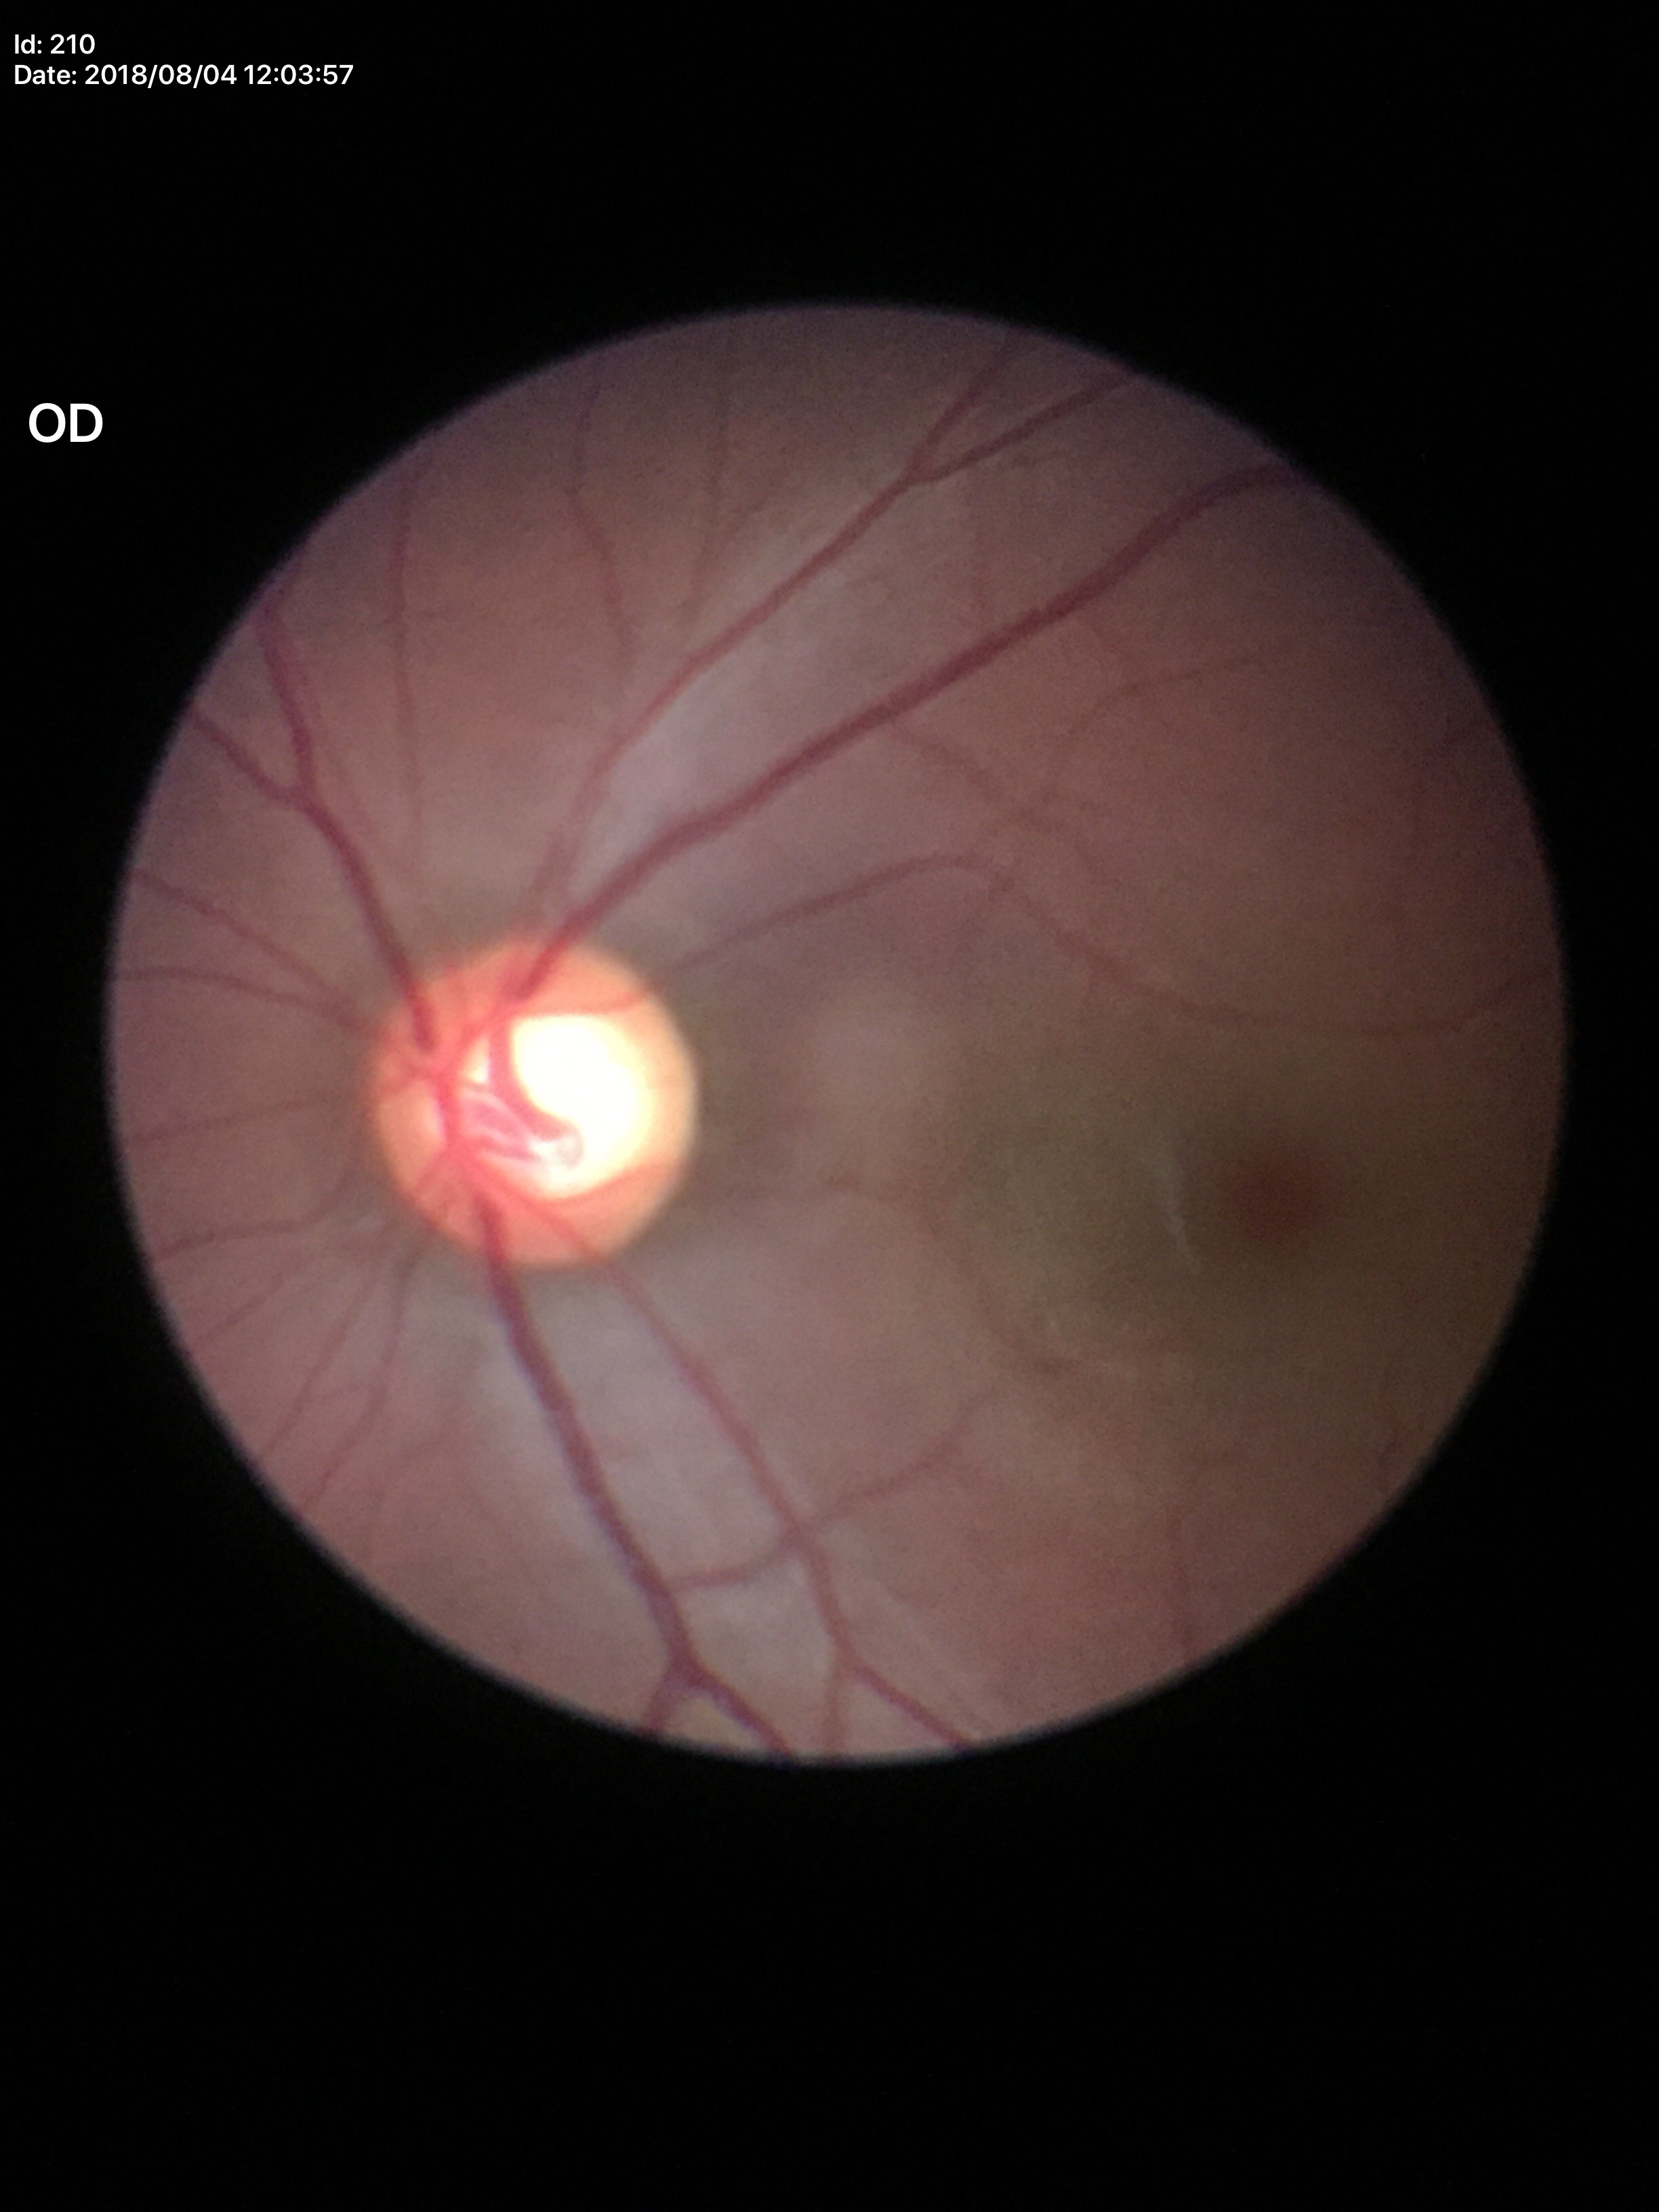 Glaucoma screening impression: suspicious findings.
VCDR: 0.62.